45° FOV, color fundus image, camera: NIDEK AFC-230, nonmydriatic — 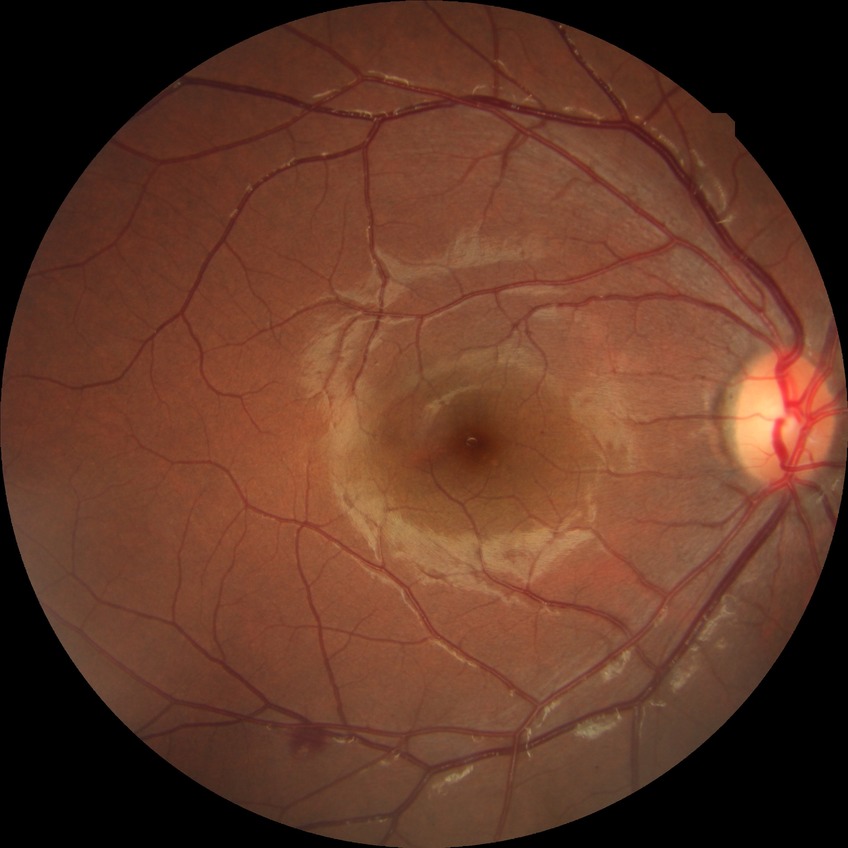
Diabetic retinopathy (DR): SDR (simple diabetic retinopathy).